640x480 · wide-field fundus photograph of an infant: 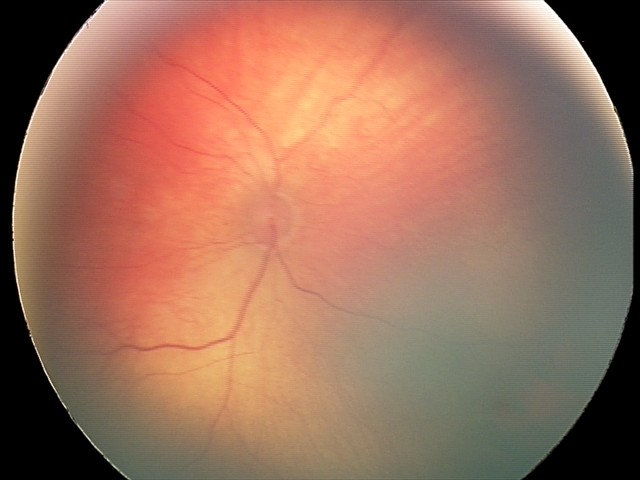
Screening diagnosis: retinal hemorrhages.